CFP
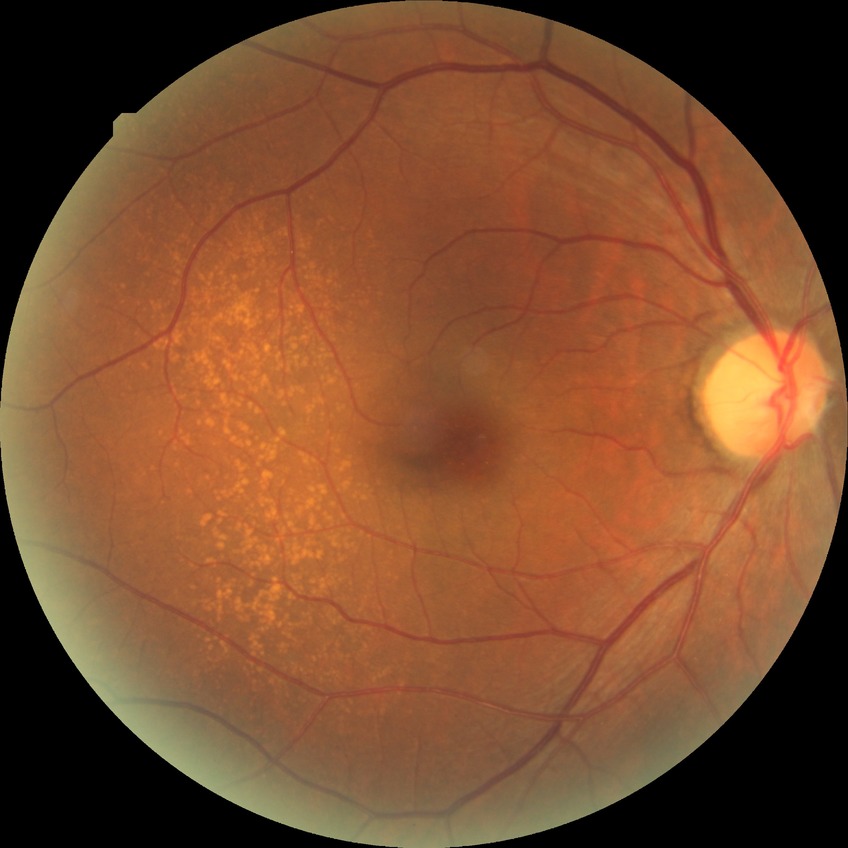
Diabetic retinopathy (DR): NDR (no diabetic retinopathy).